130° field of view (Natus RetCam Envision). Wide-field contact fundus photograph of an infant: 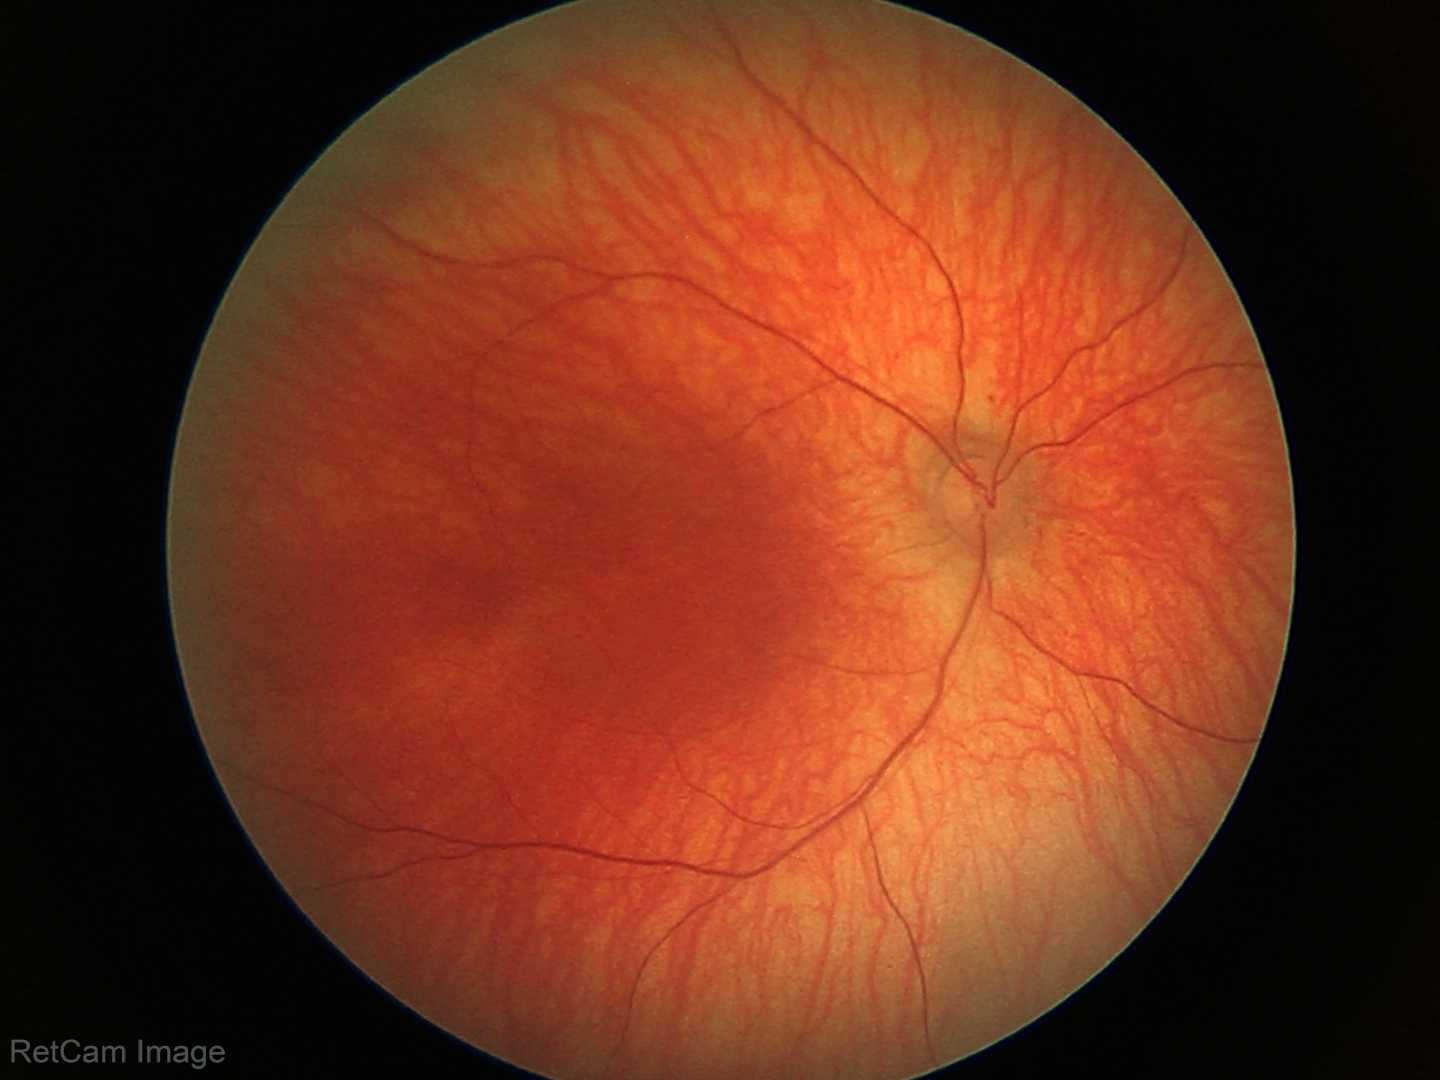 Assessment: no abnormal retinal findings.